Captured with the Phoenix ICON (100° field of view). Wide-field fundus photograph of an infant.
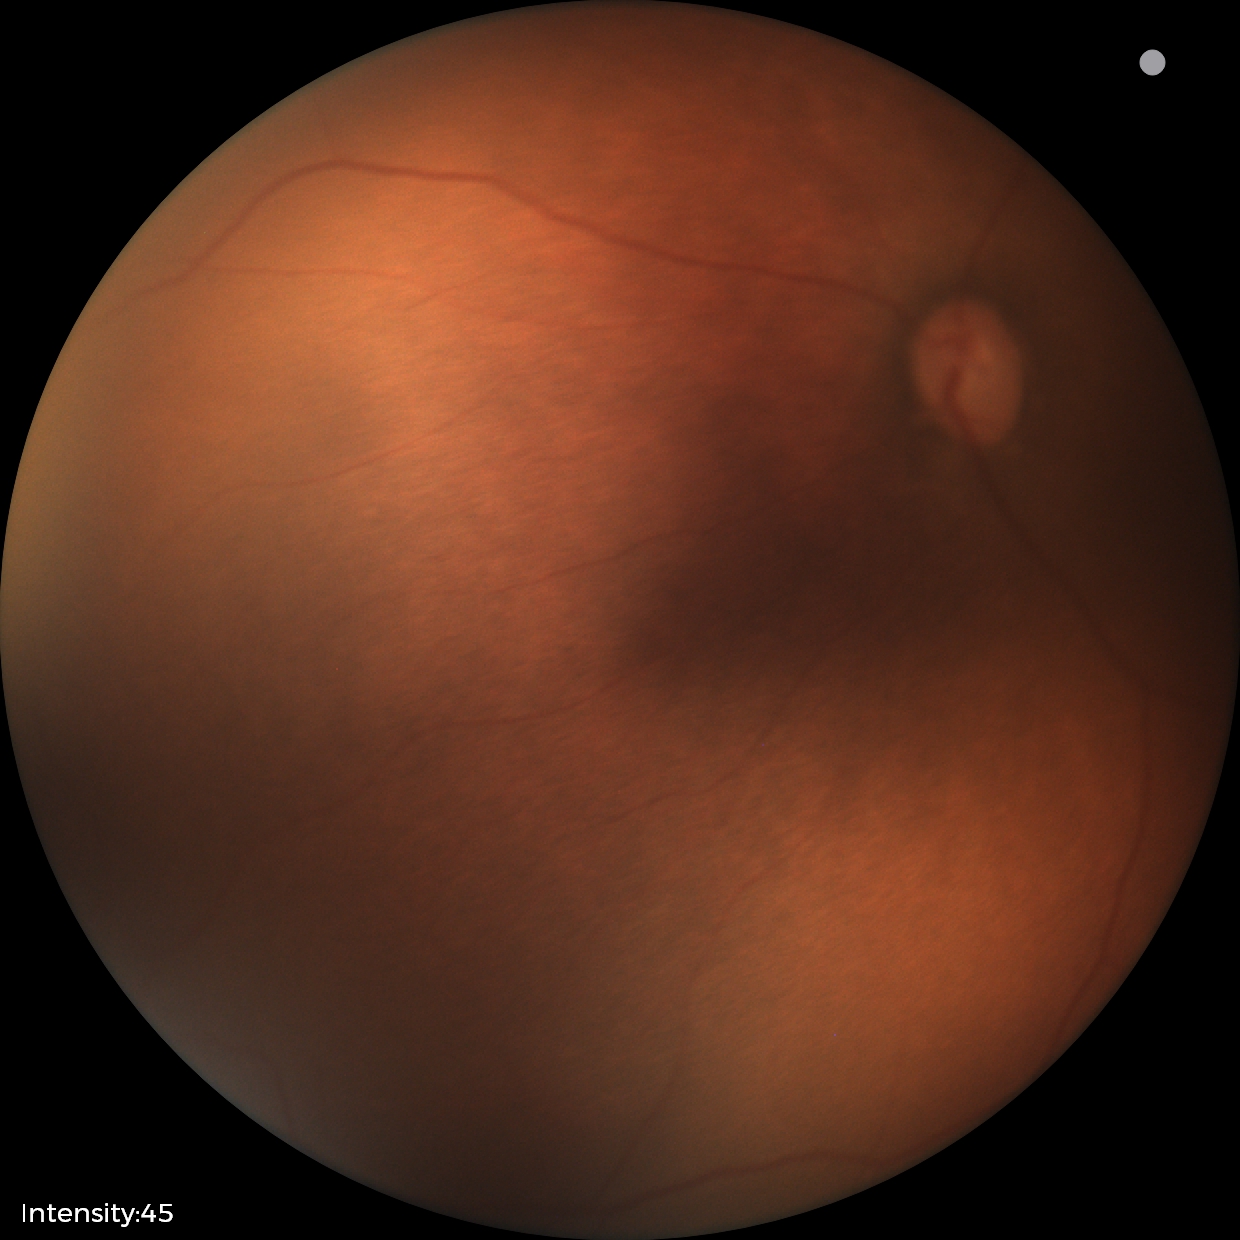 Q: Plus disease status?
A: no plus disease — posterior pole vessels without abnormal dilation or tortuosity
Q: What is the screening diagnosis?
A: retinopathy of prematurity (ROP) stage 2